848x848, camera: NIDEK AFC-230
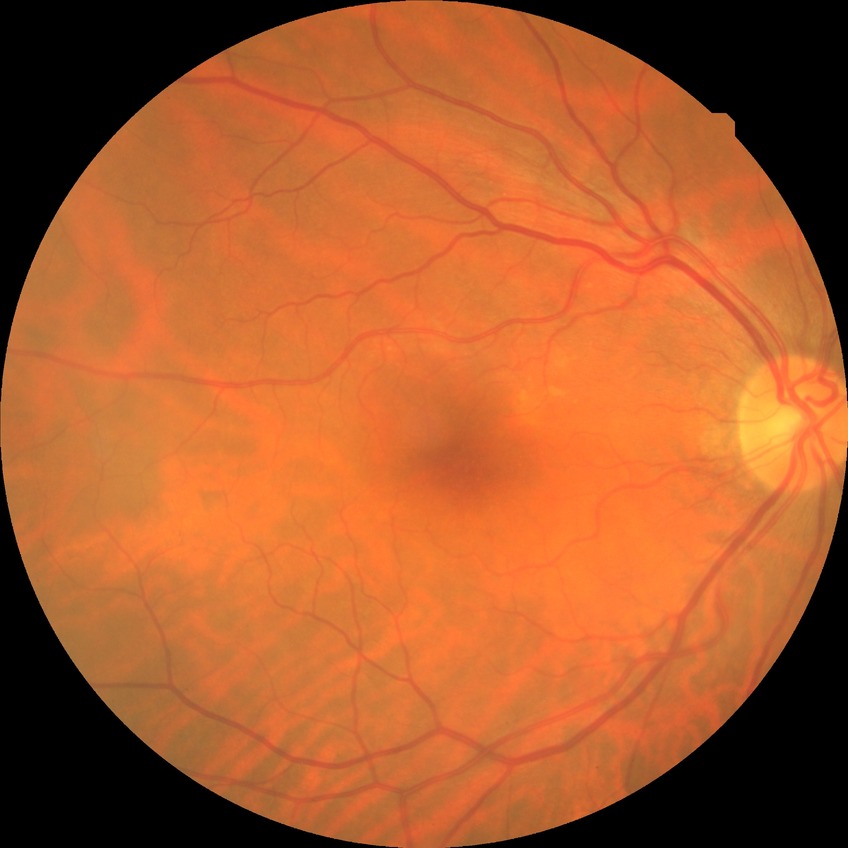
Retinopathy grade: no diabetic retinopathy.